Phoenix ICON, 100° FOV. Wide-field fundus photograph from neonatal ROP screening.
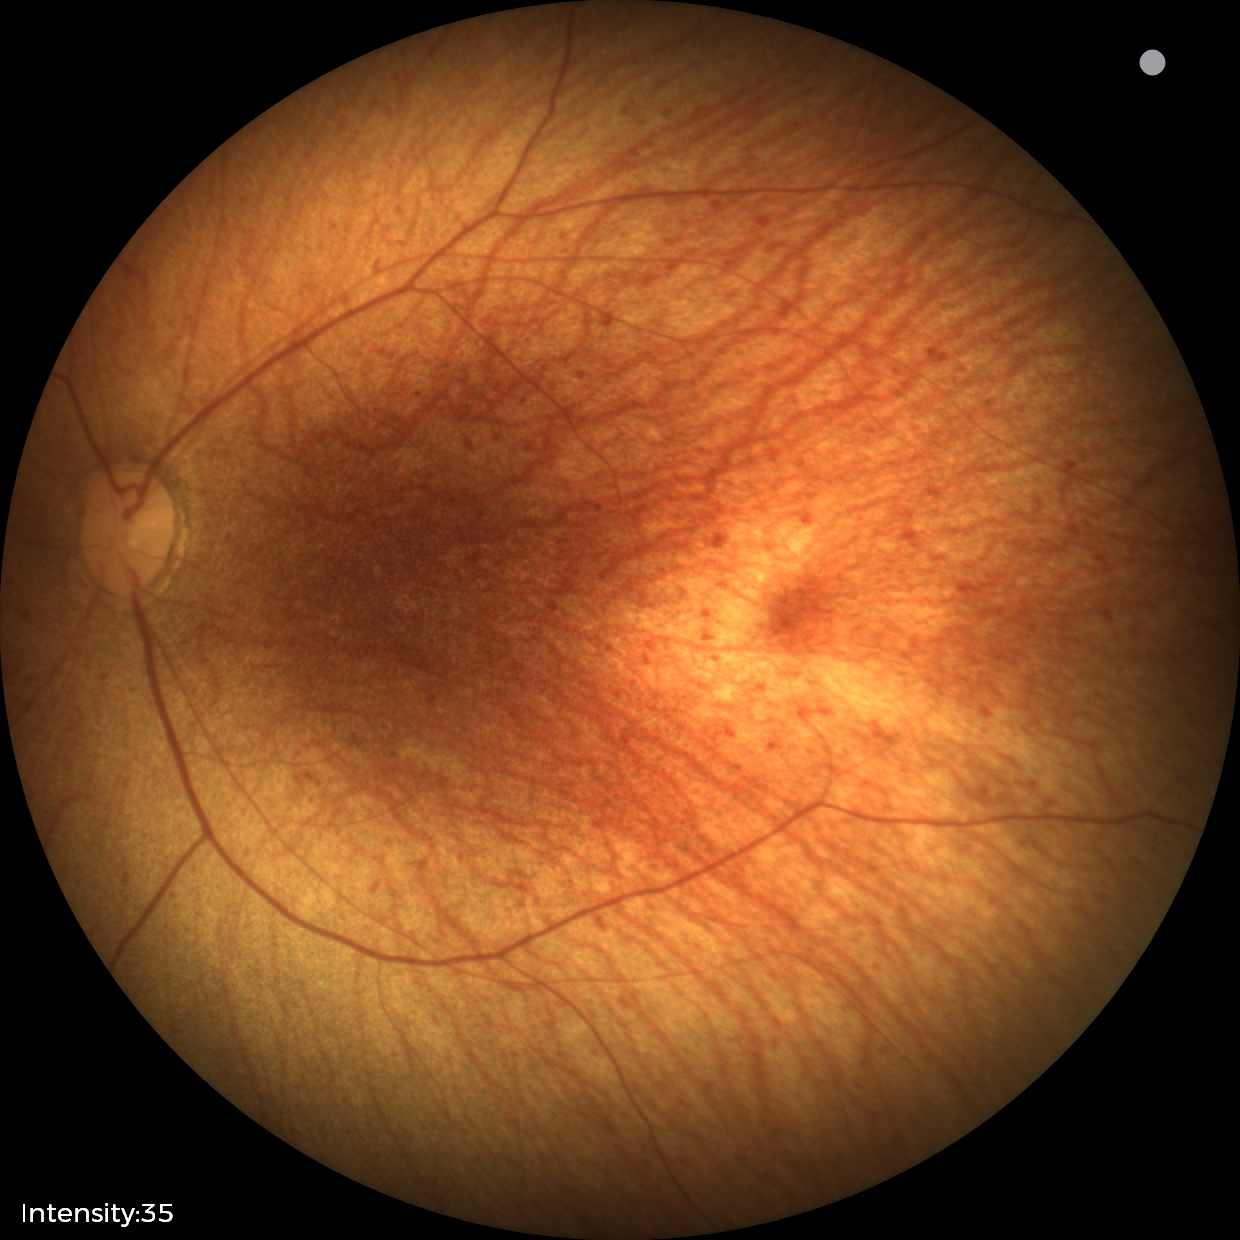
Finding = physiological